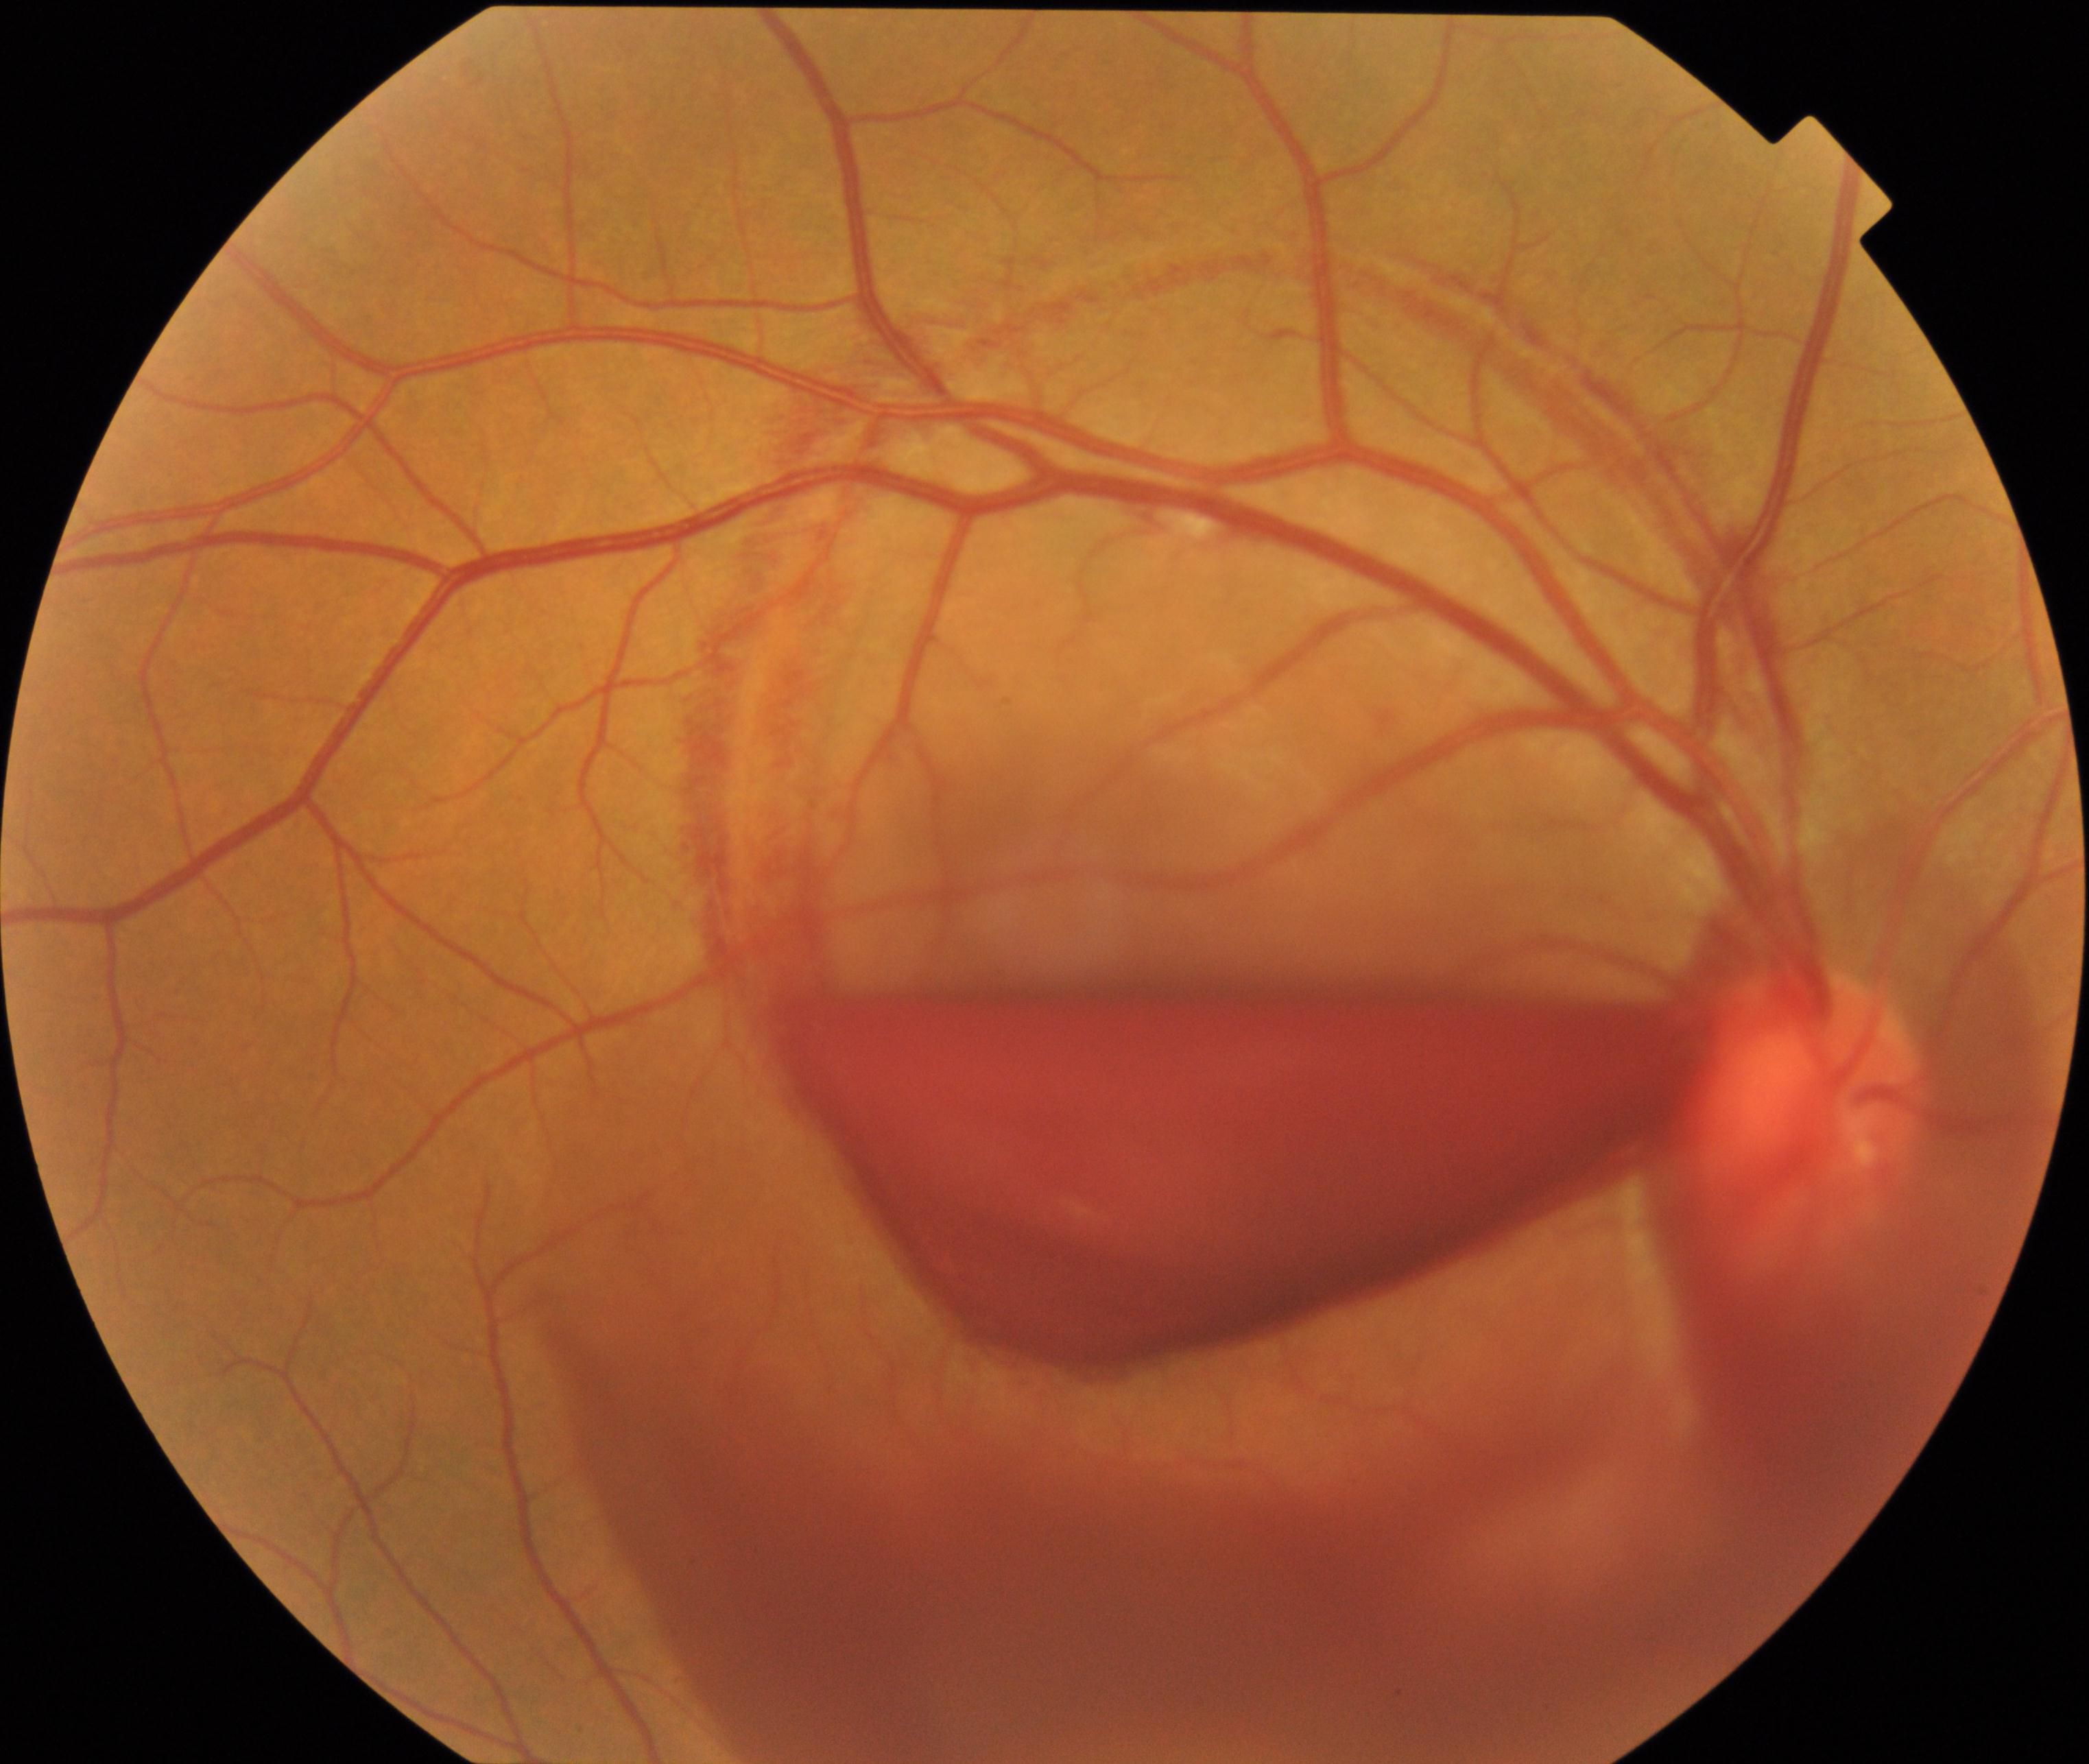

Diagnosis: preretinal hemorrhage.